Infant wide-field fundus photograph
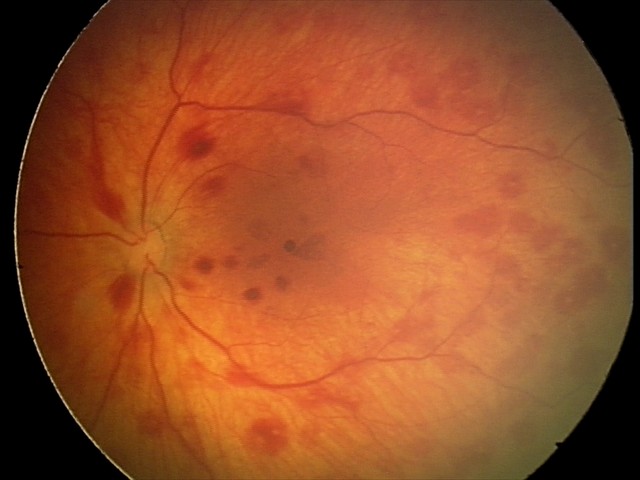
Diagnosis from this screening exam: retinal hemorrhages.